Image size 2352x1568; 45° FOV: 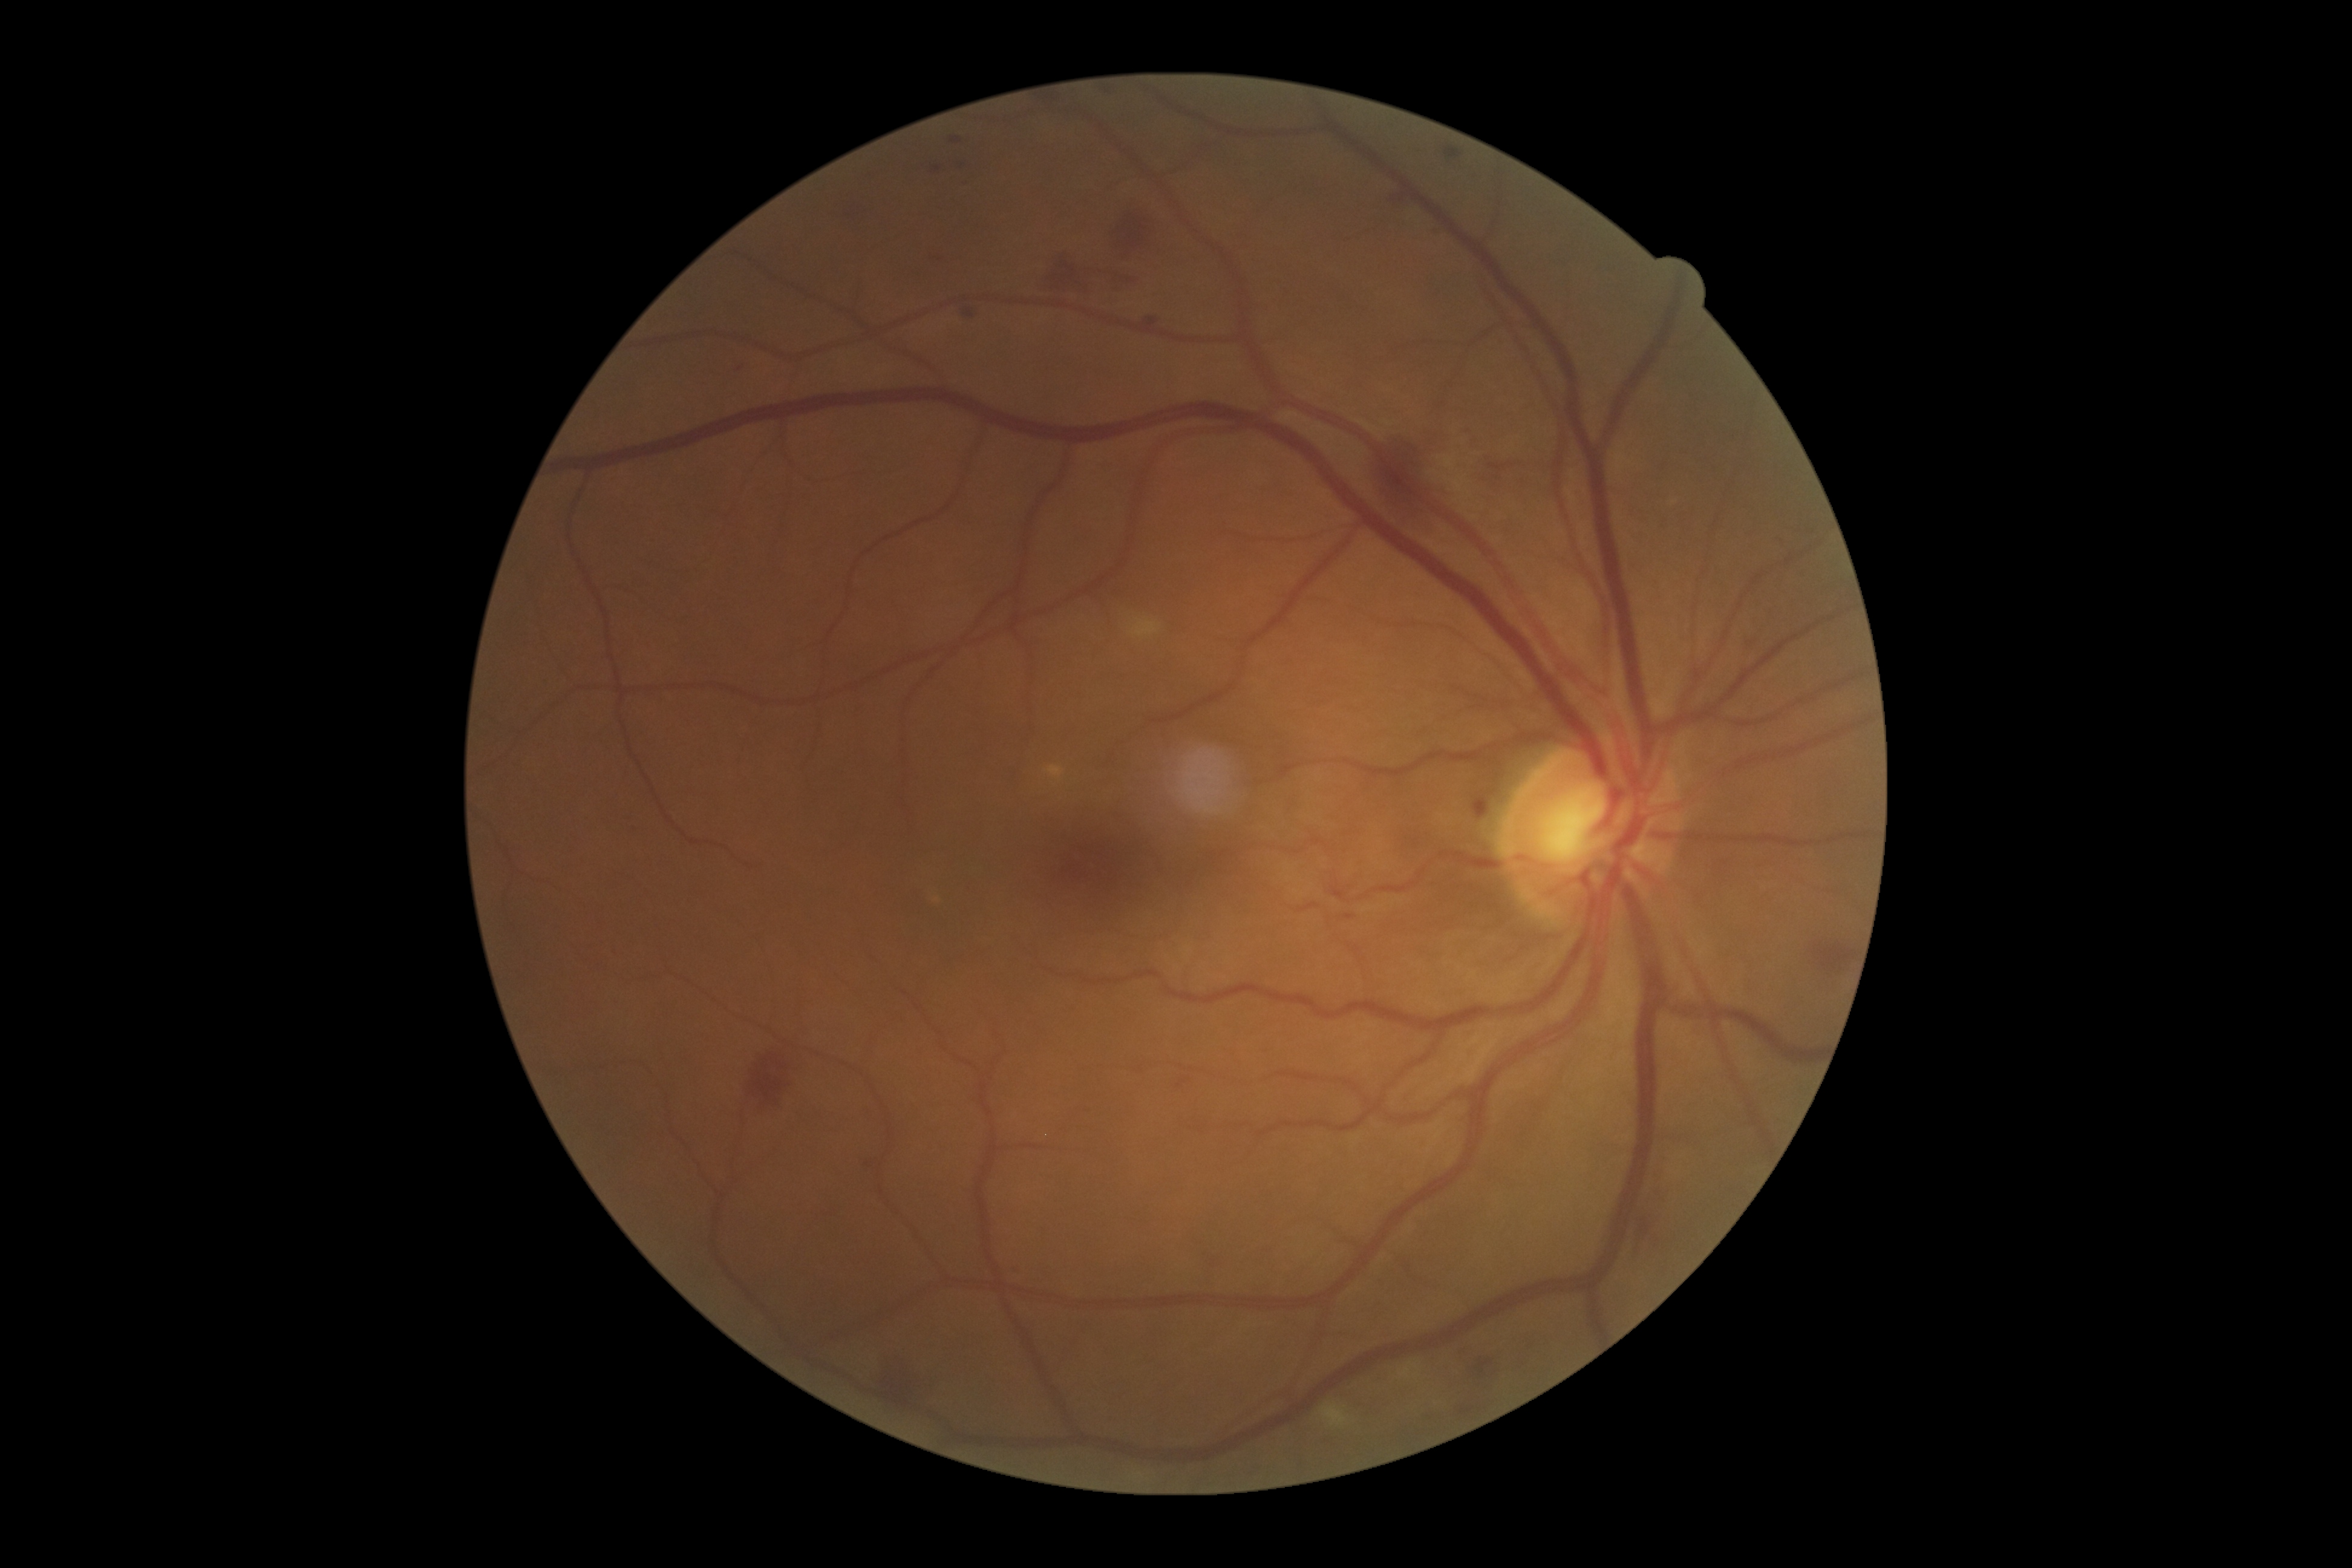 {
  "dr_category": "non-proliferative diabetic retinopathy",
  "dr_grade": "grade 2 (moderate NPDR) — more than just microaneurysms but less than severe NPDR"
}